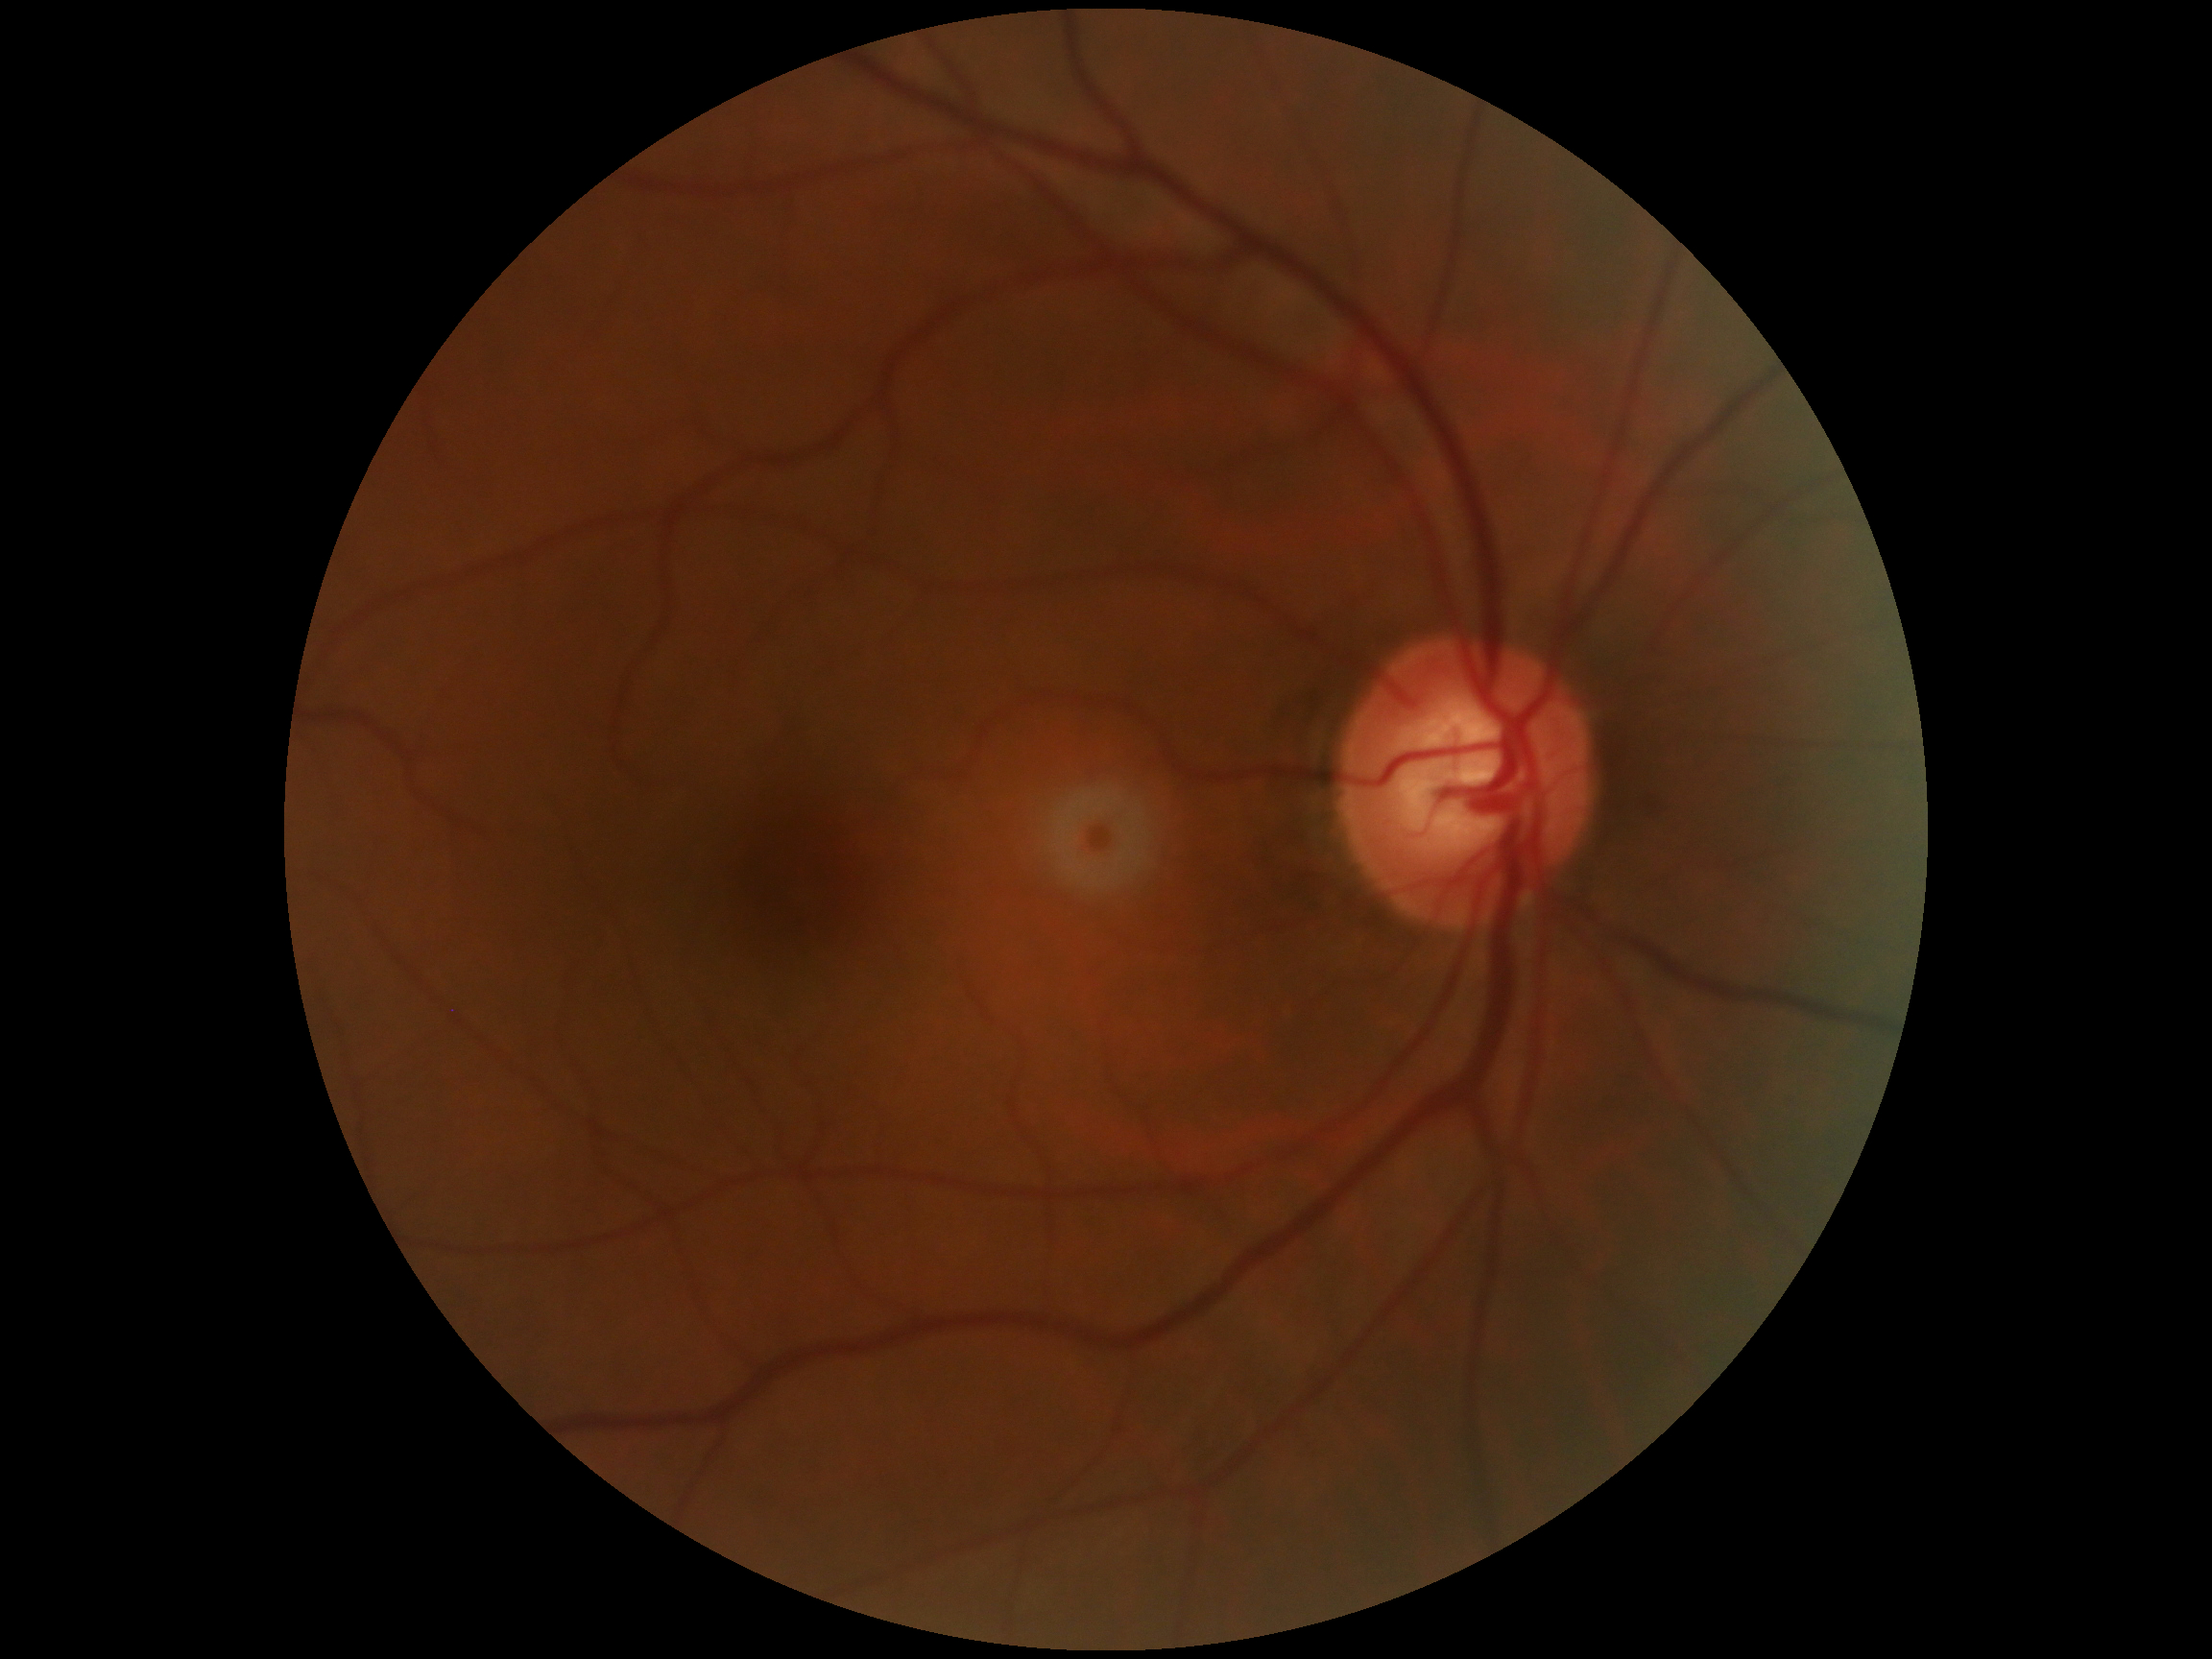
DR grade: 0 (no apparent retinopathy). No signs of diabetic retinopathy.